45° FOV.
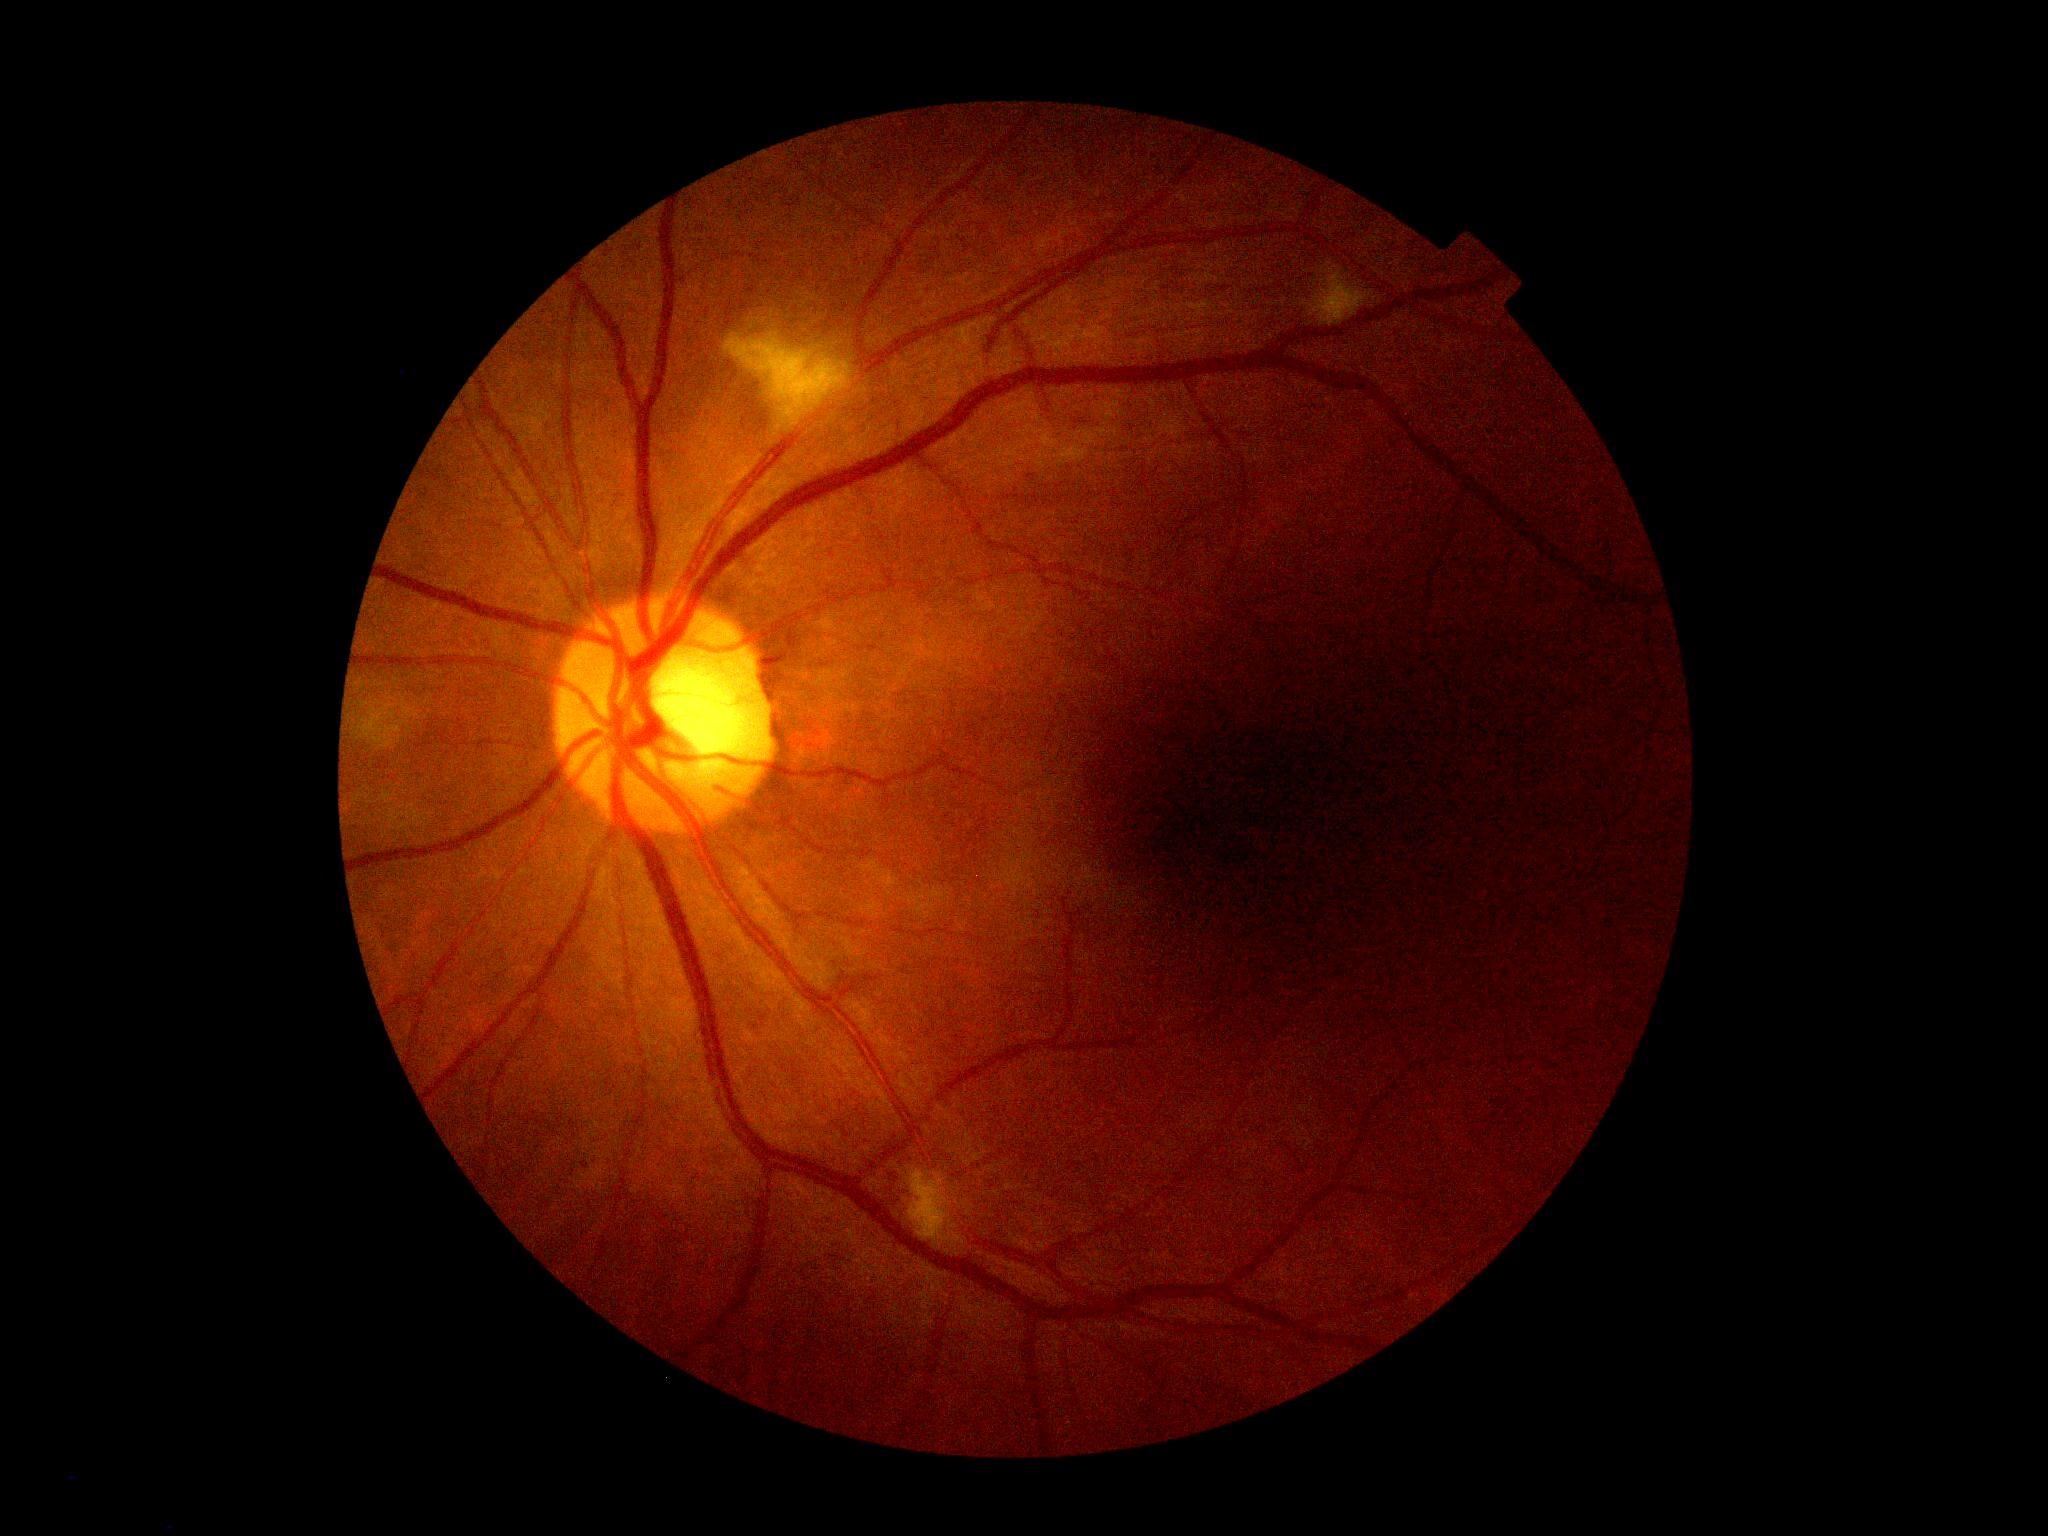
Diabetic retinopathy severity is grade 2.